CFP
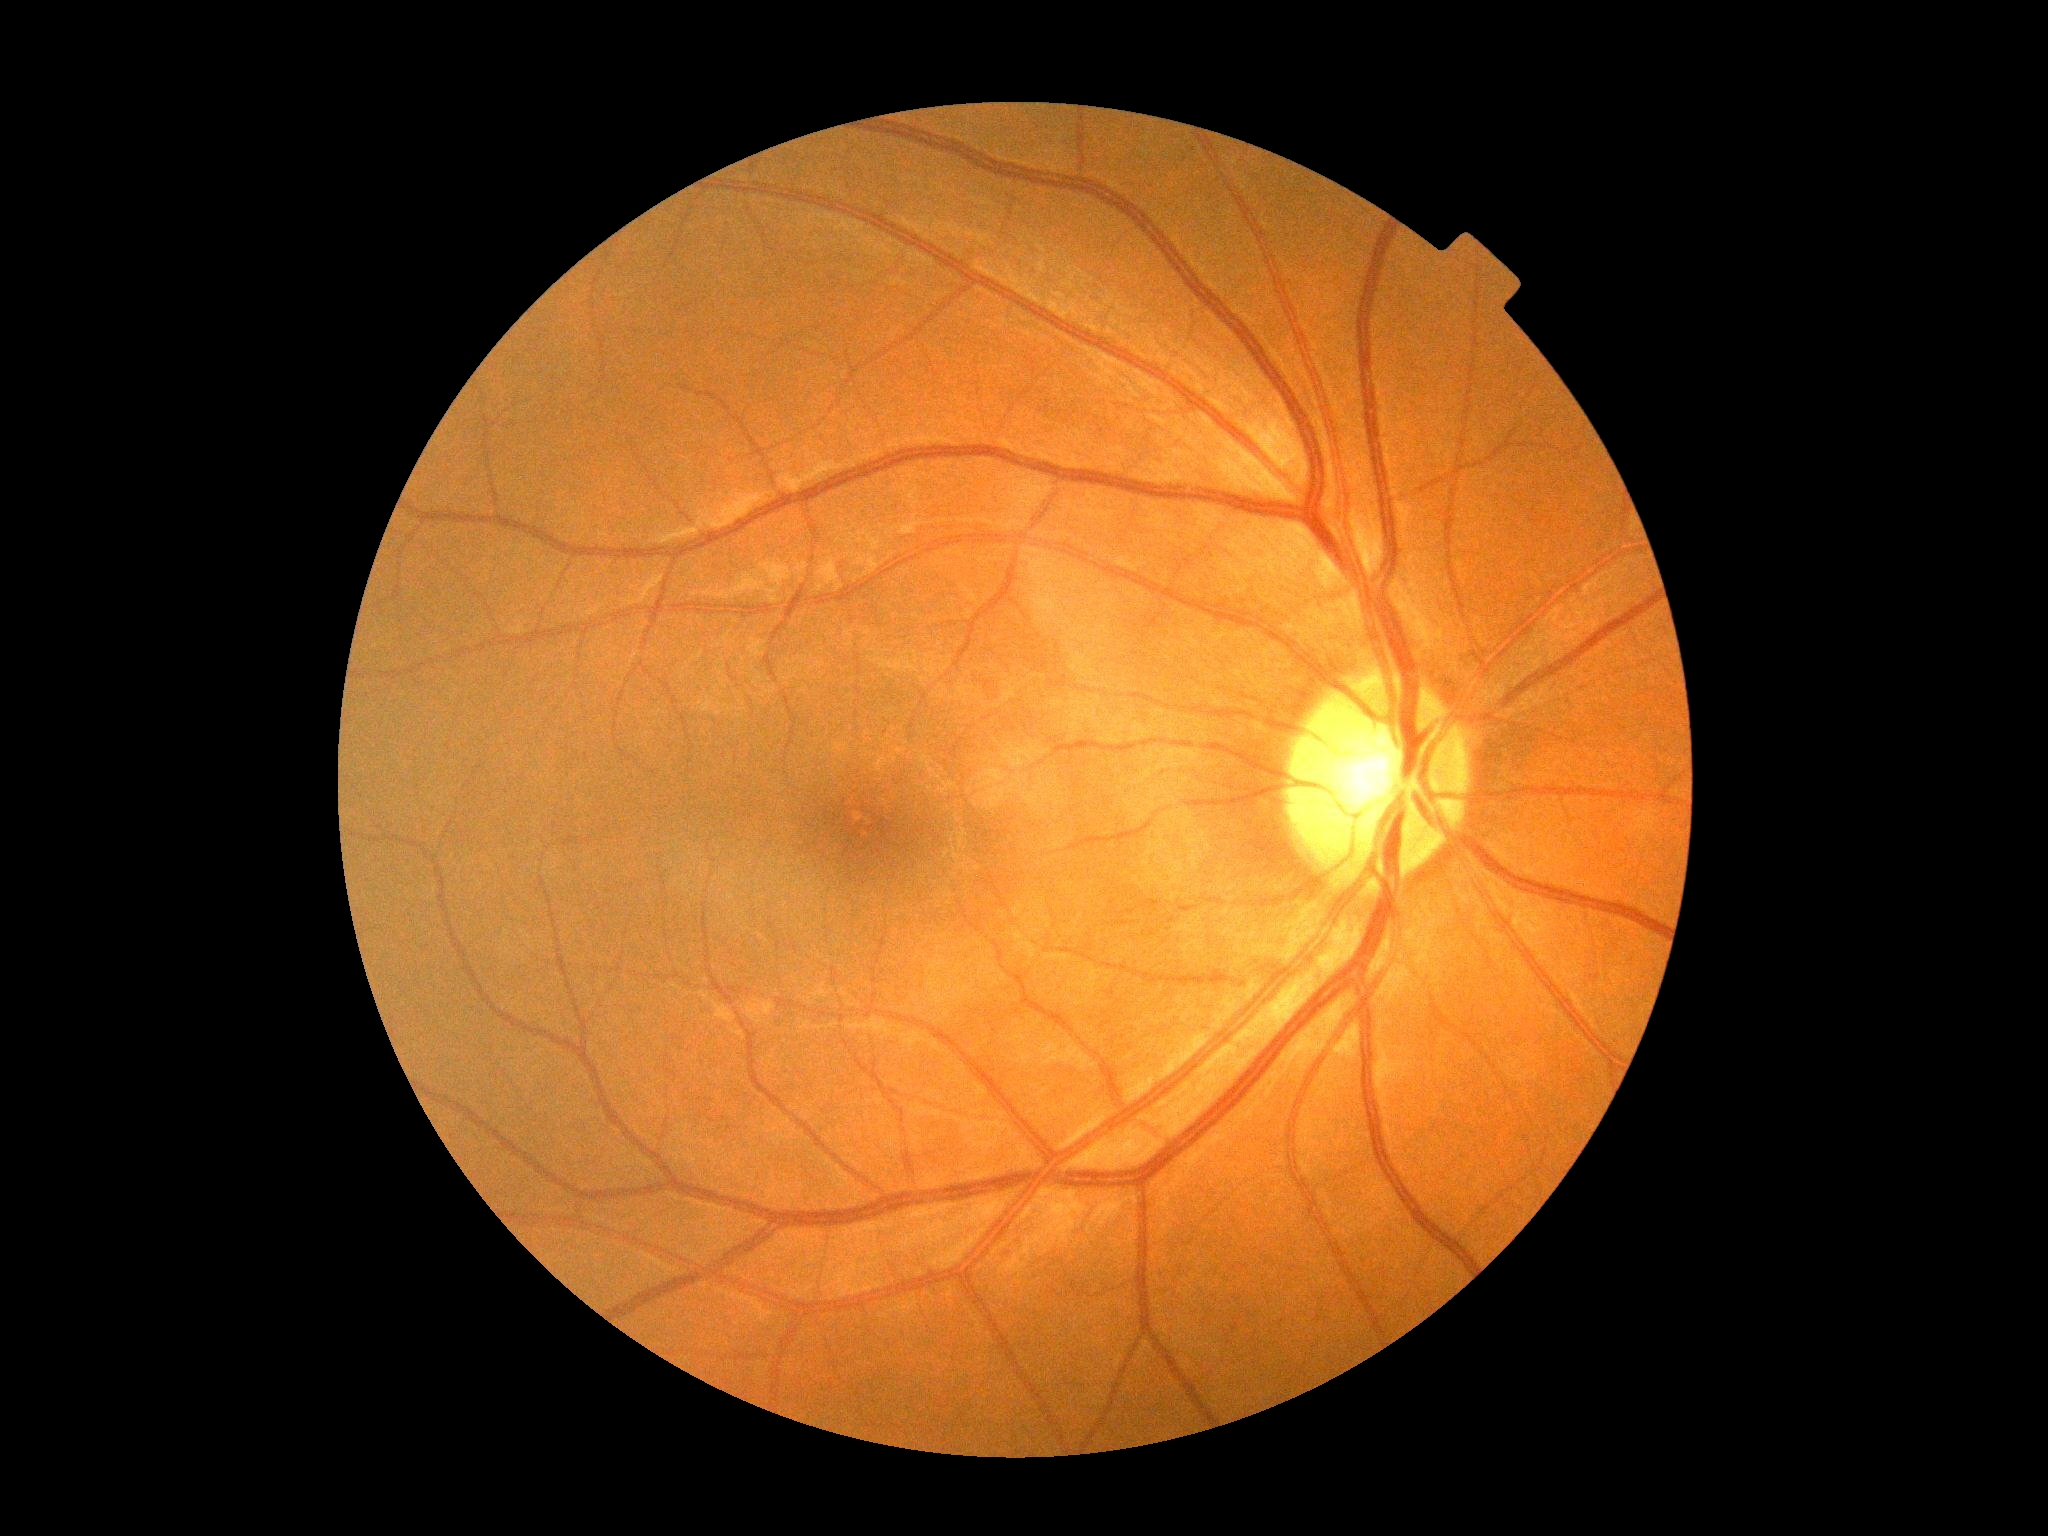 DR stage@grade 0 (no apparent retinopathy).